Wide-field fundus image from infant ROP screening. Acquired on the Phoenix ICON. 1240x1240px
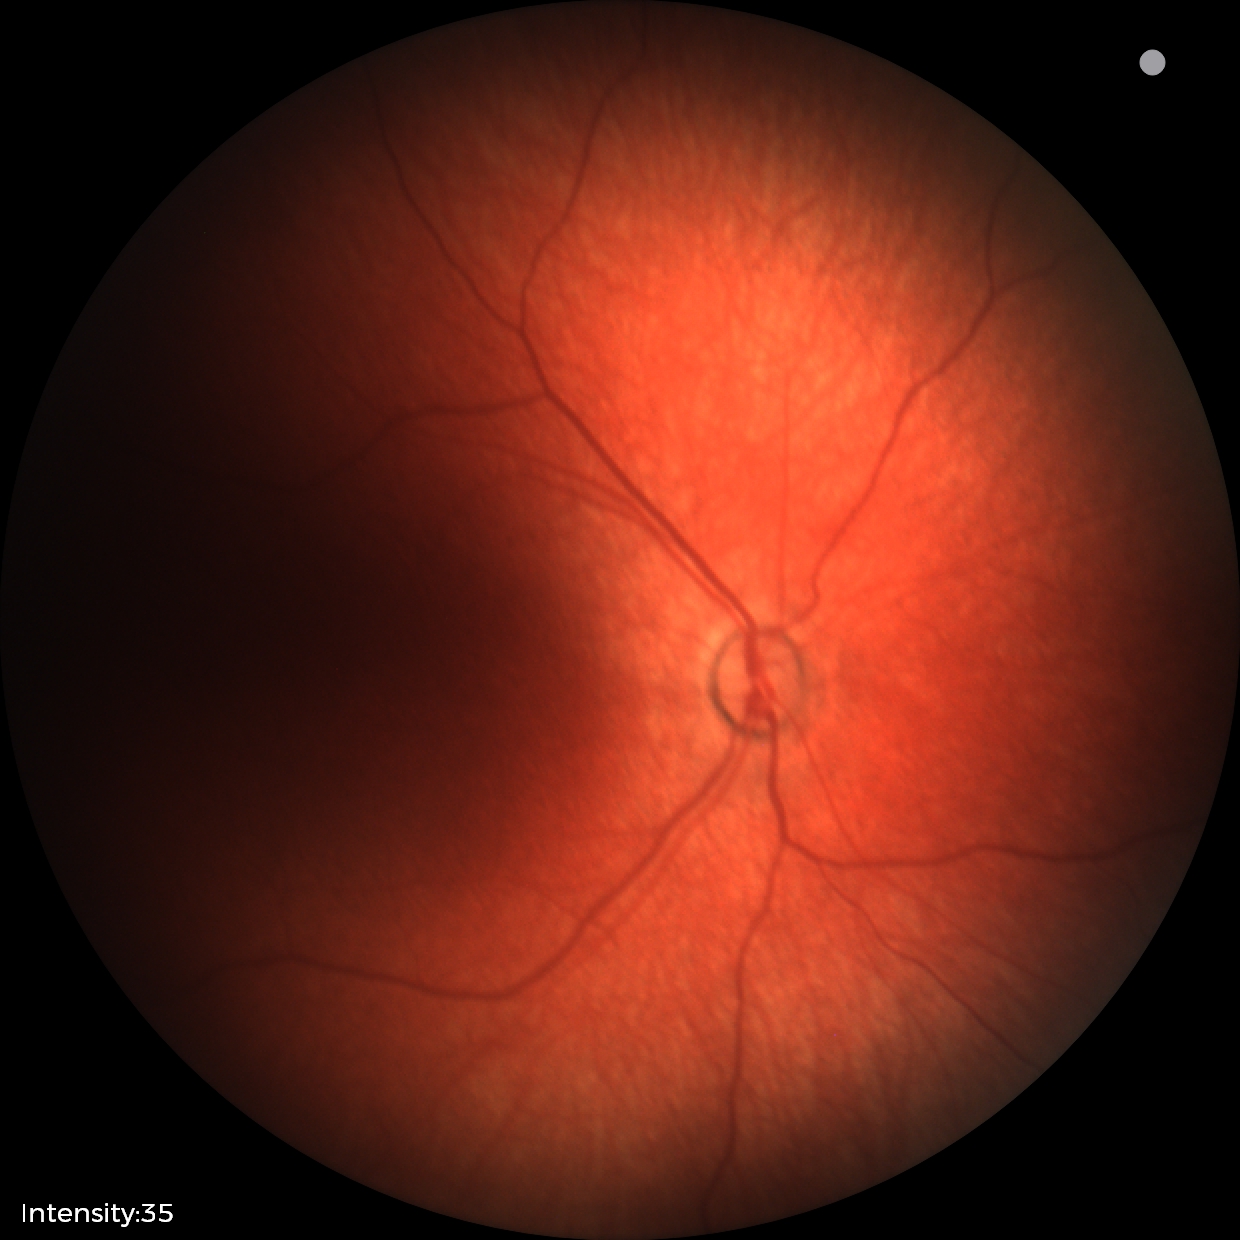
Physiological retinal appearance for postconceptual age.